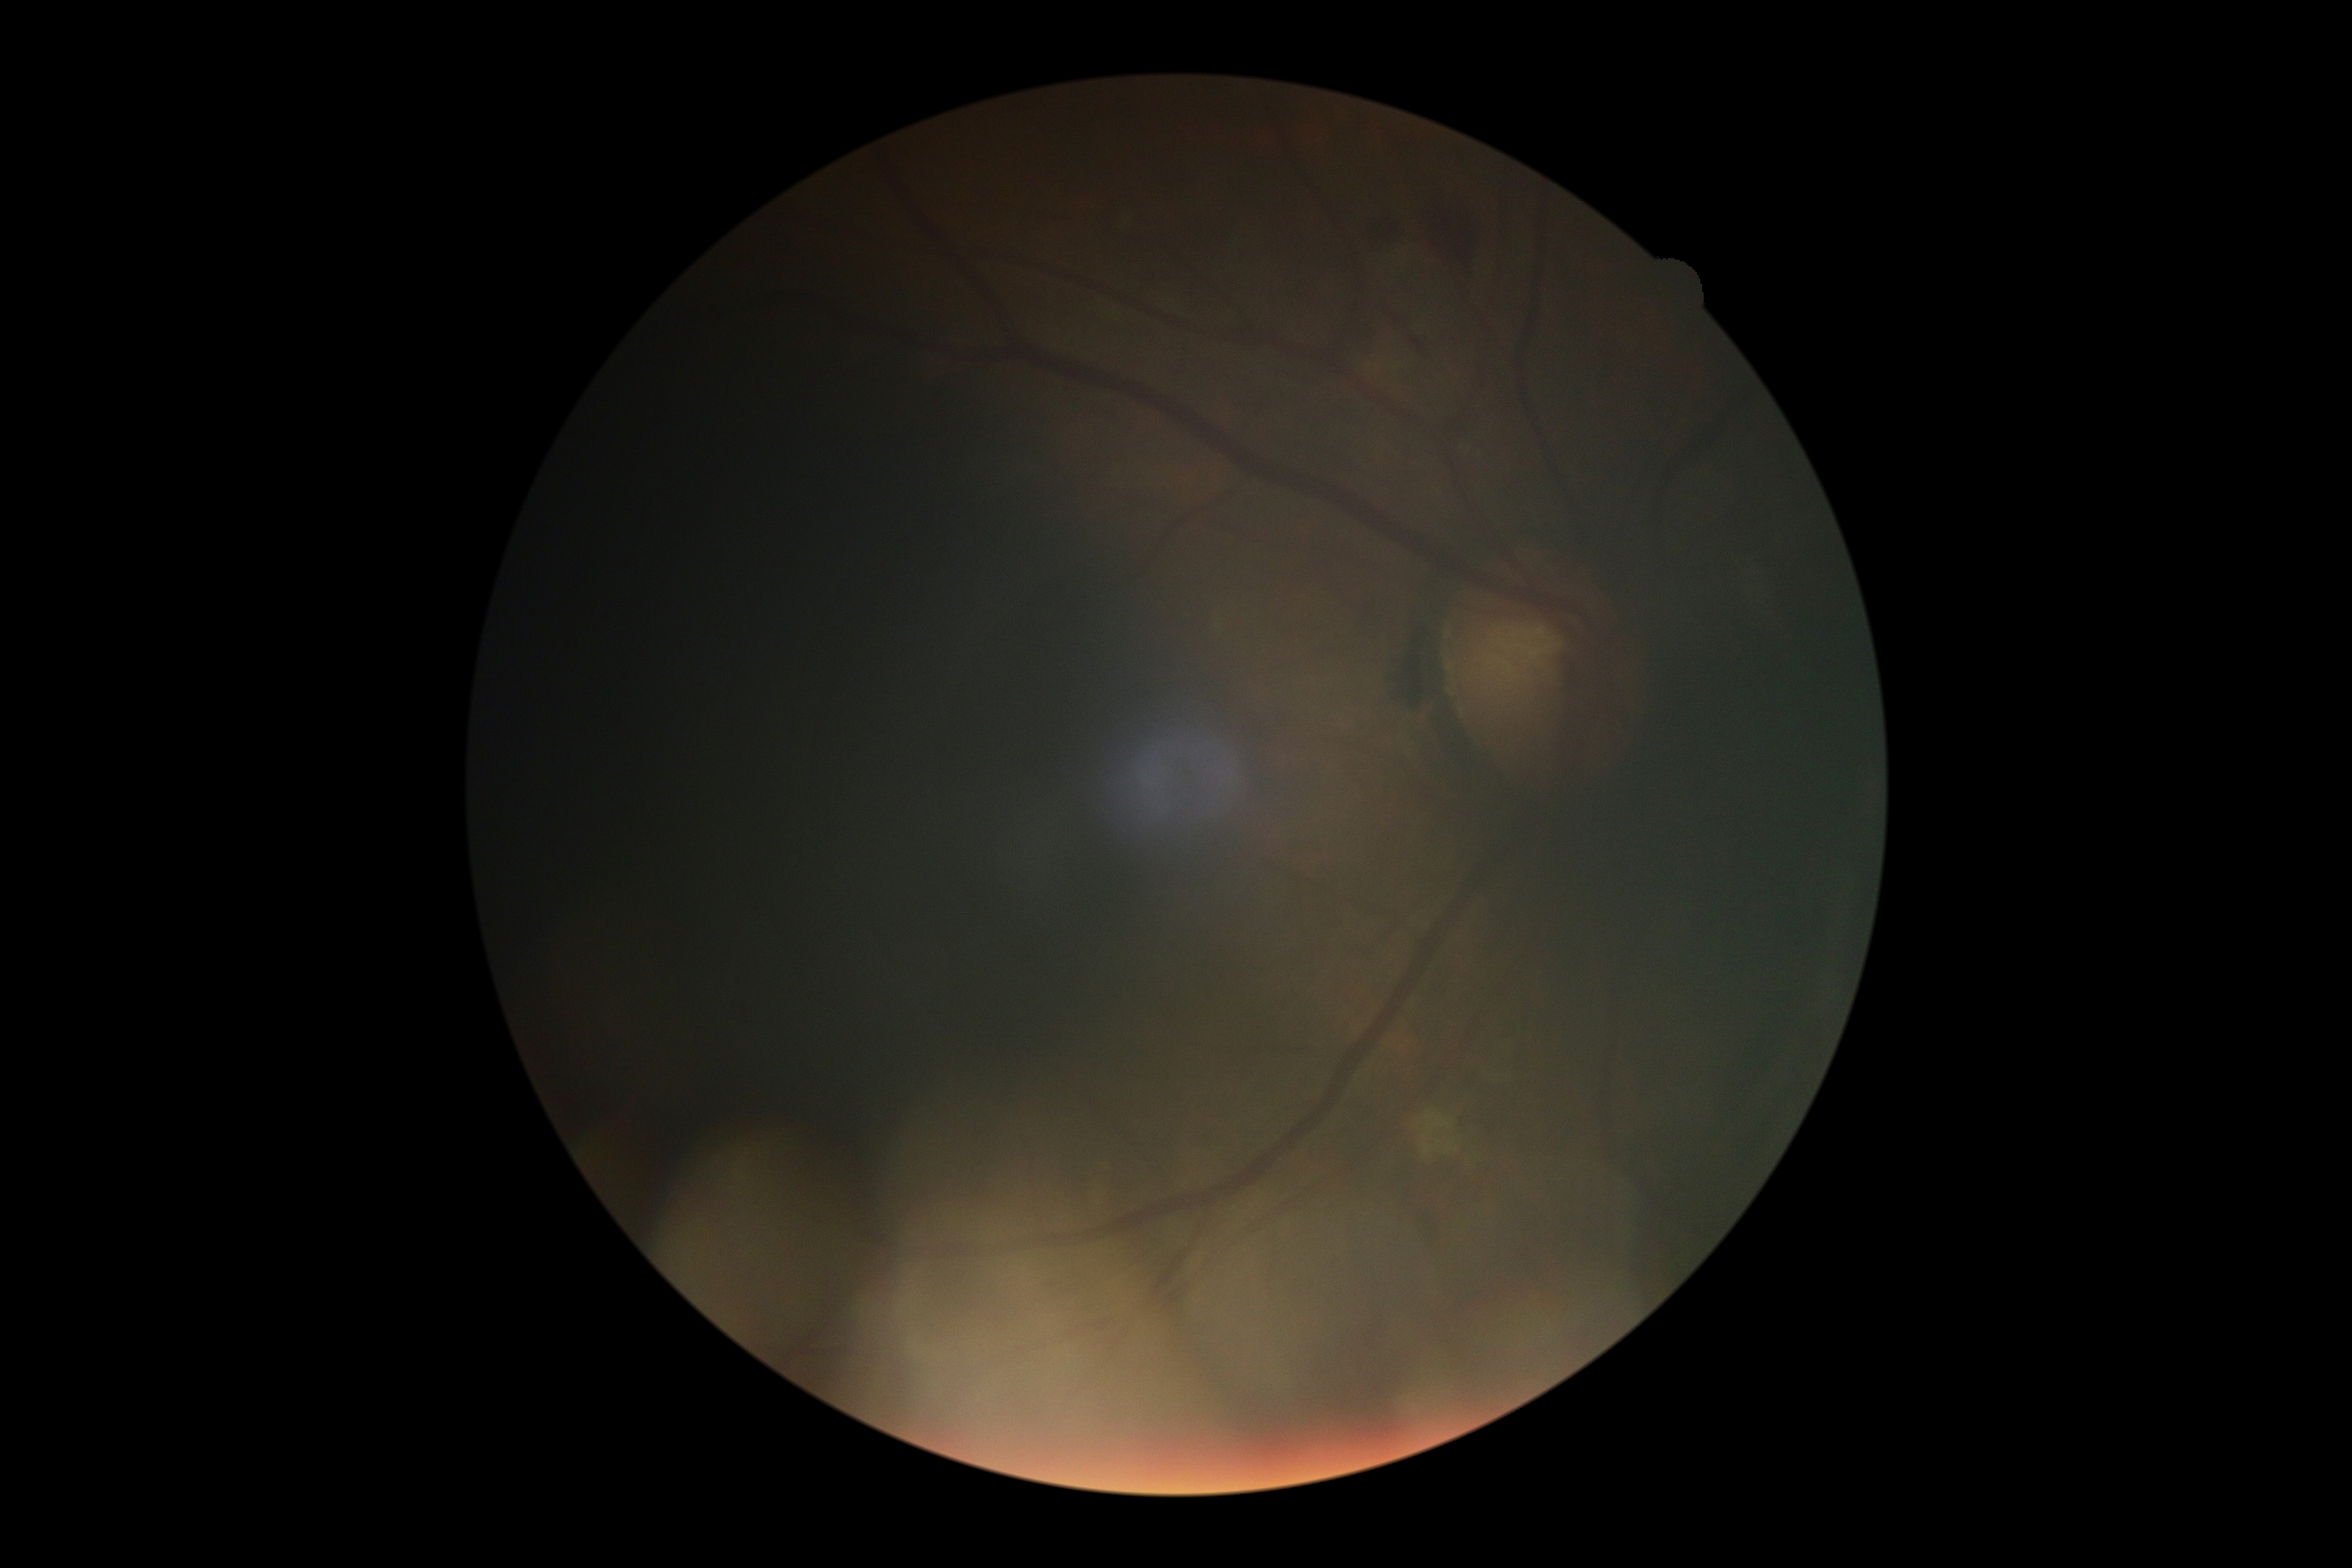 Diabetic retinopathy: grade 2 (moderate NPDR).